Davis DR grading.
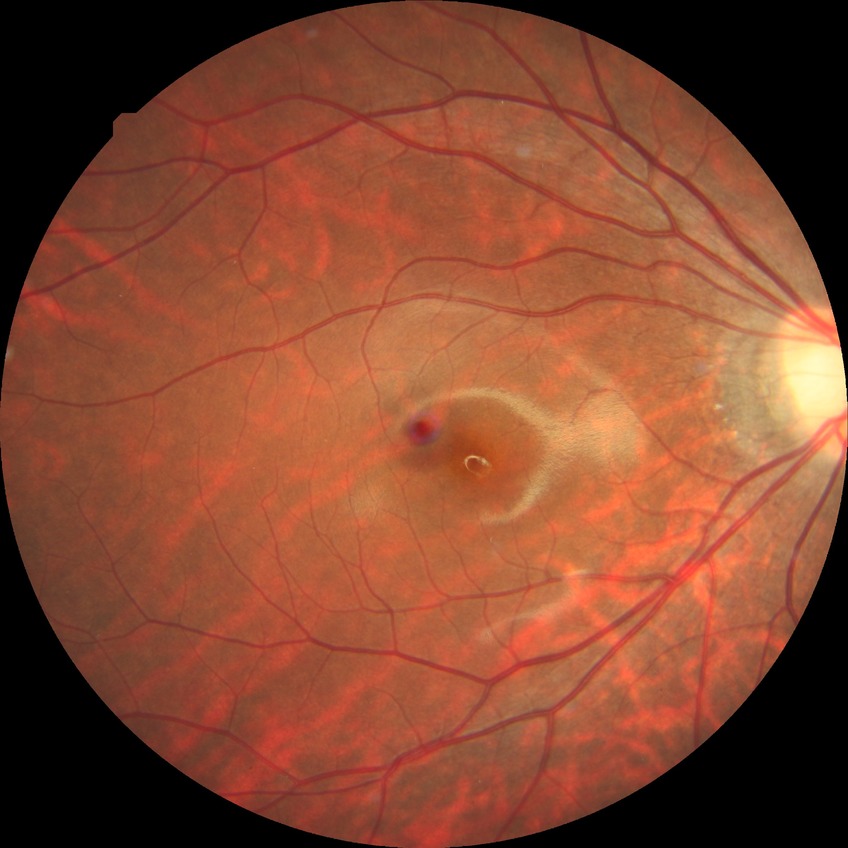

Diabetic retinopathy grade is no diabetic retinopathy.